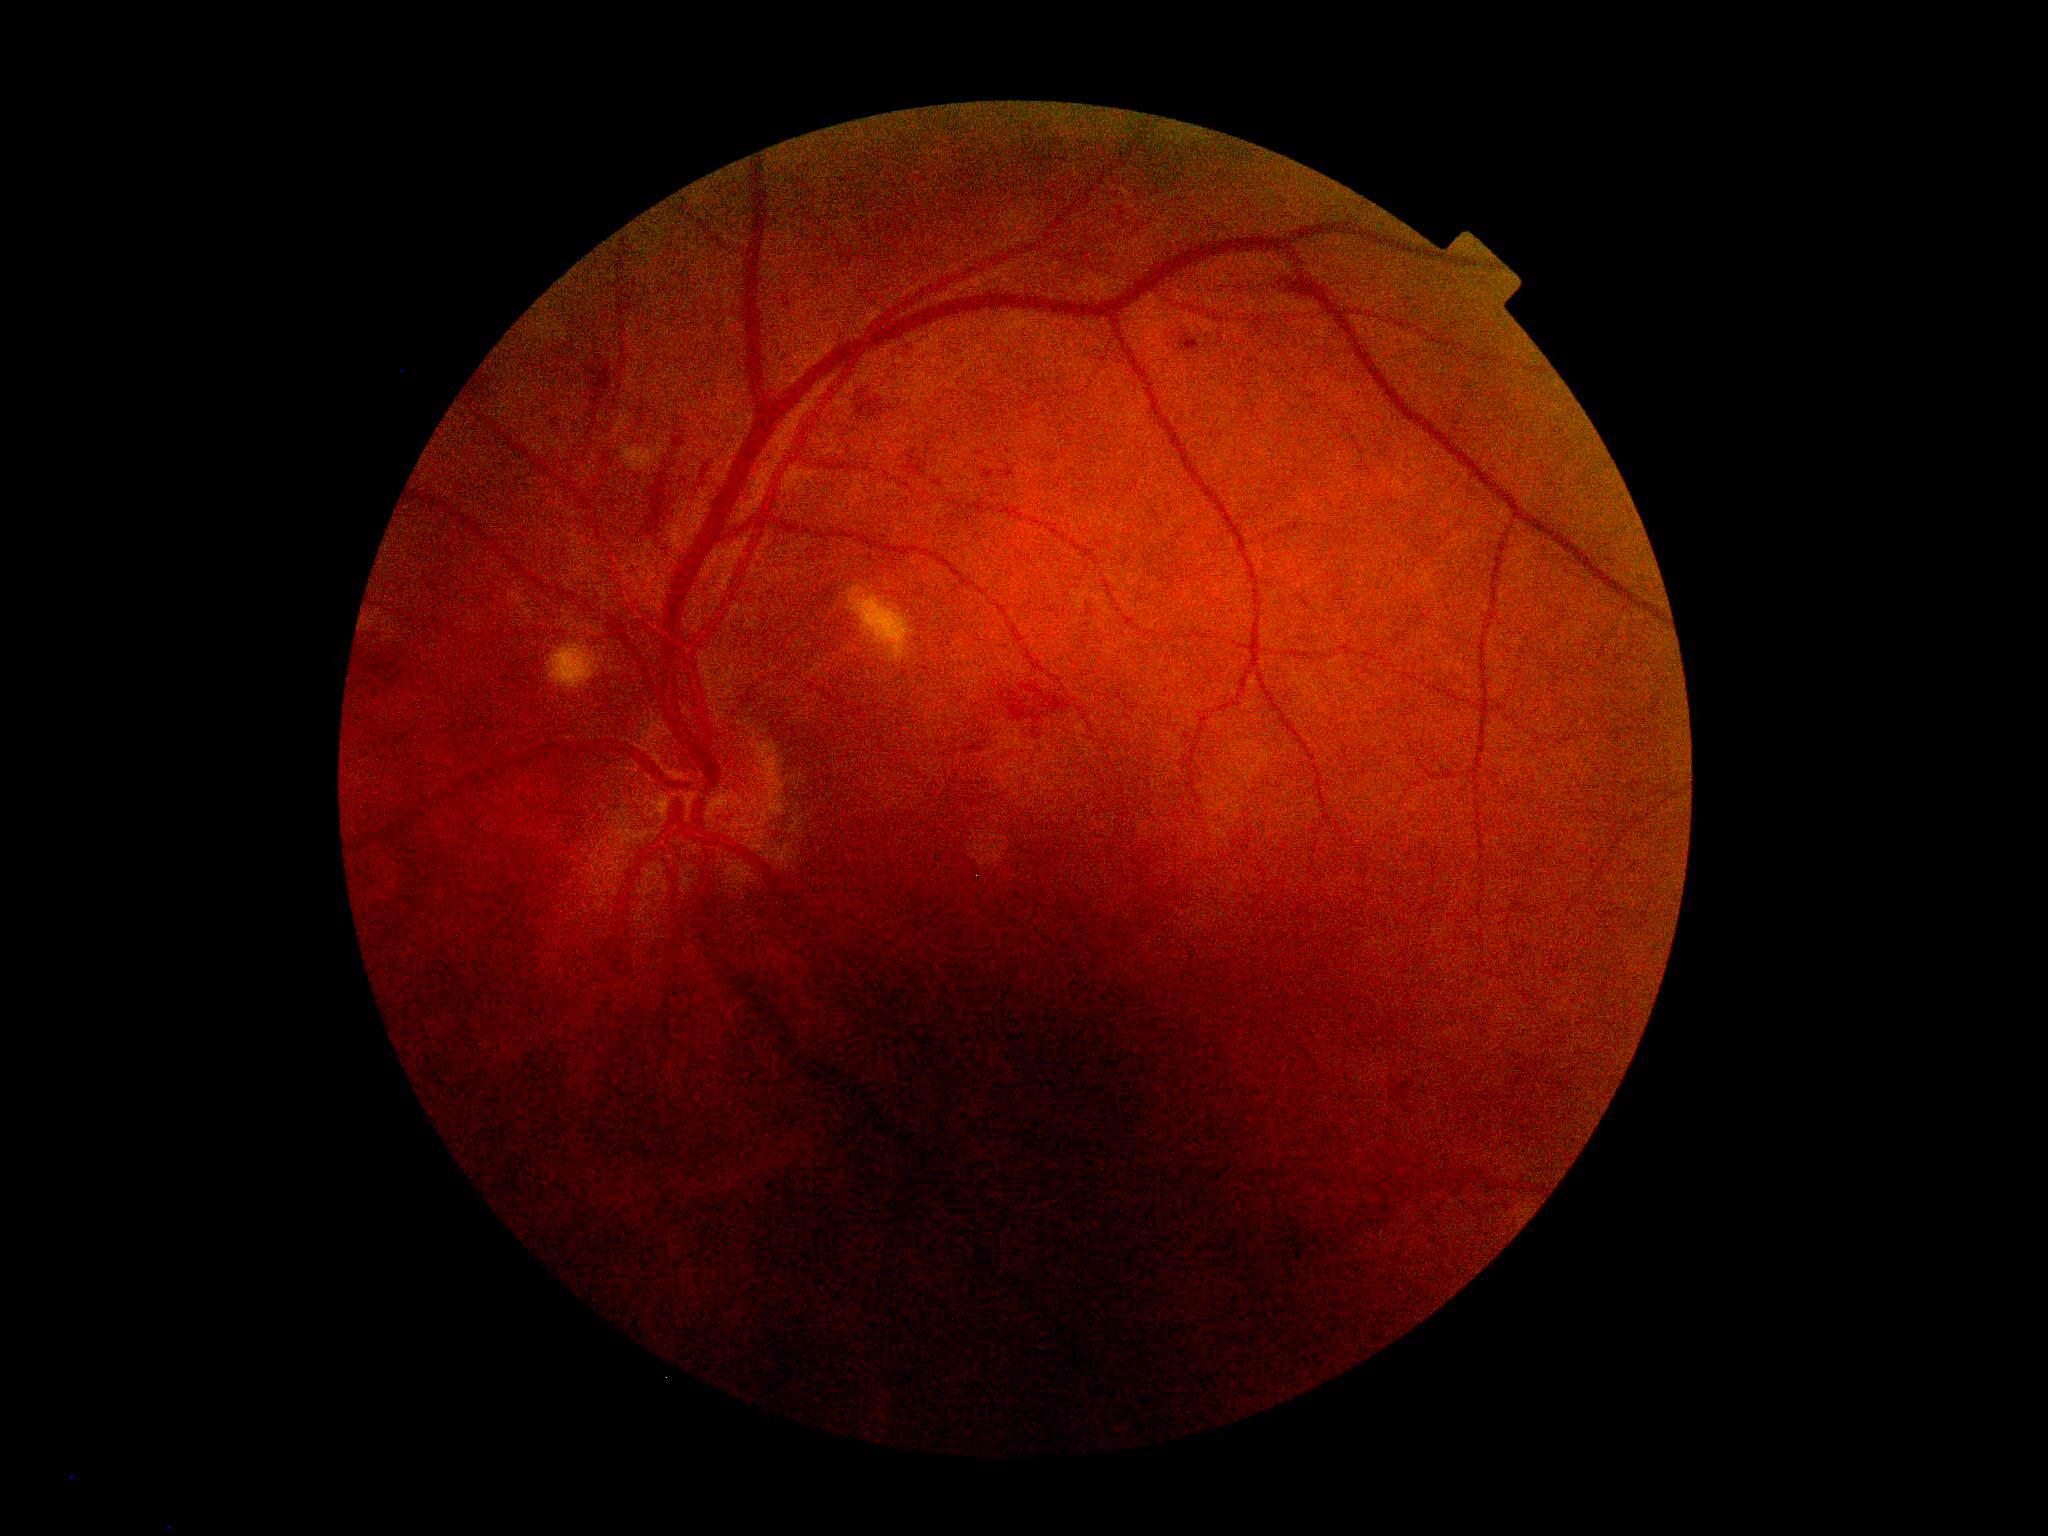 DR@grade 2.